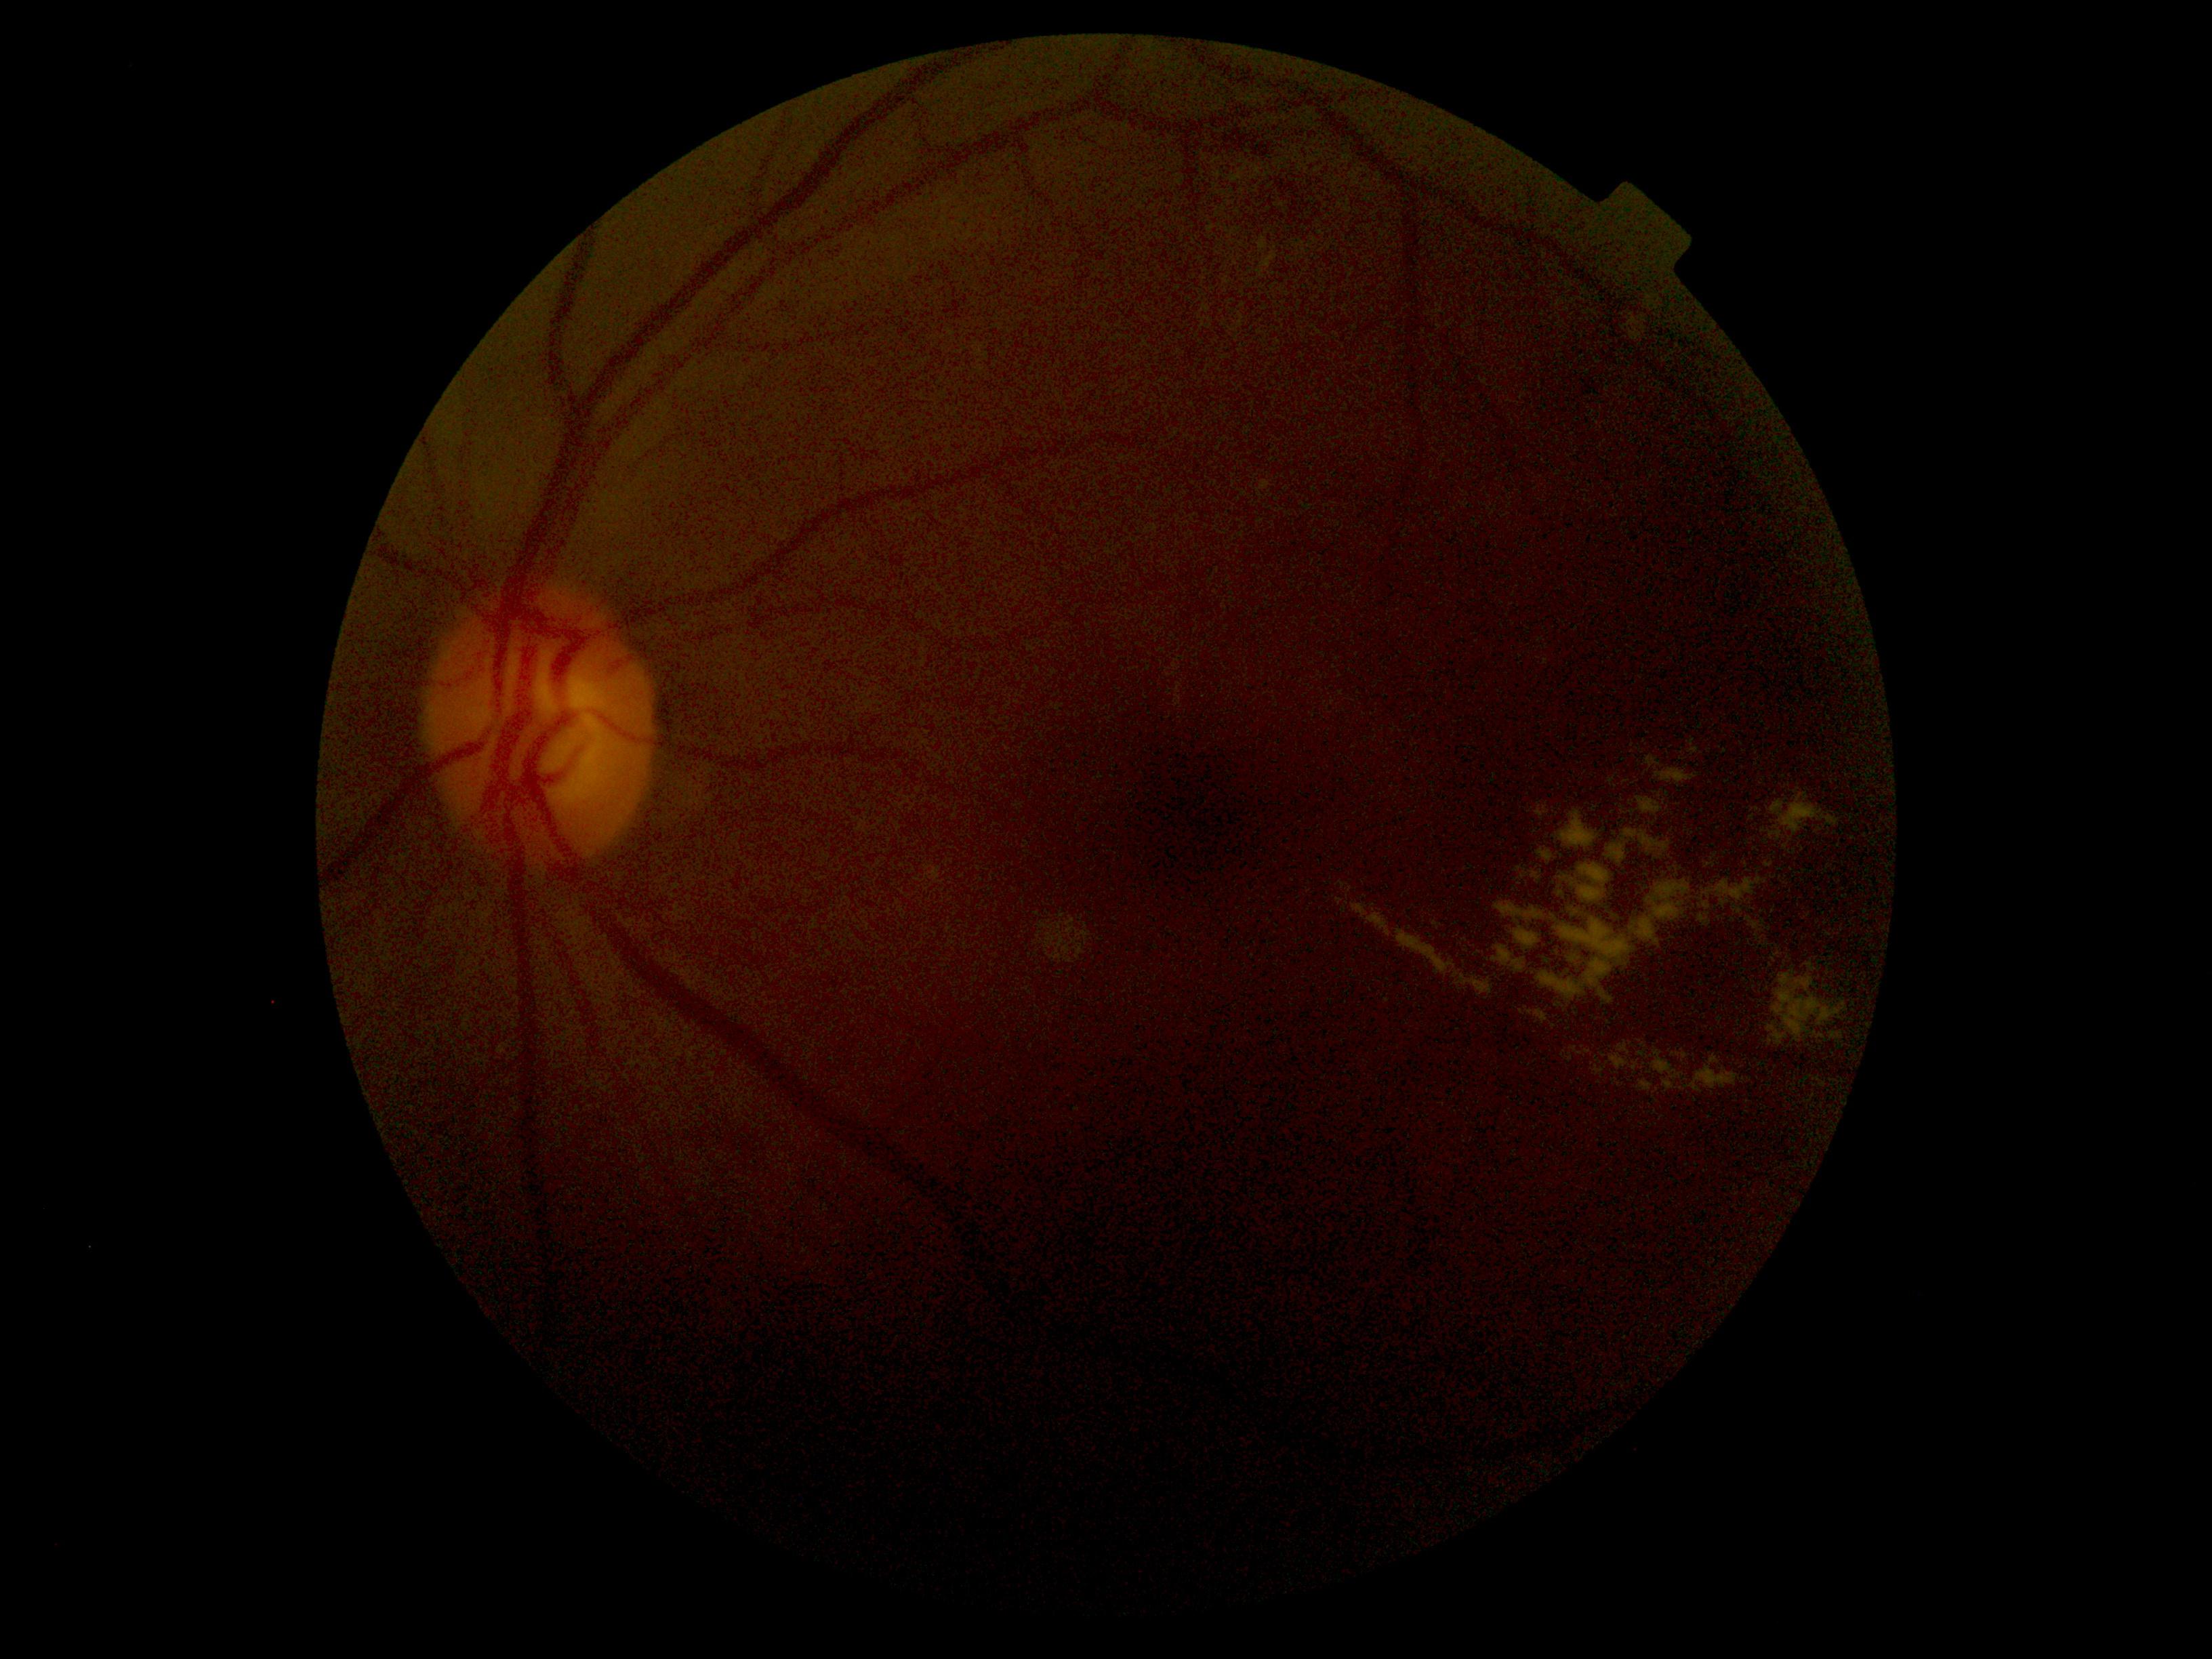 DR stage: 2/4. DR class: non-proliferative diabetic retinopathy.